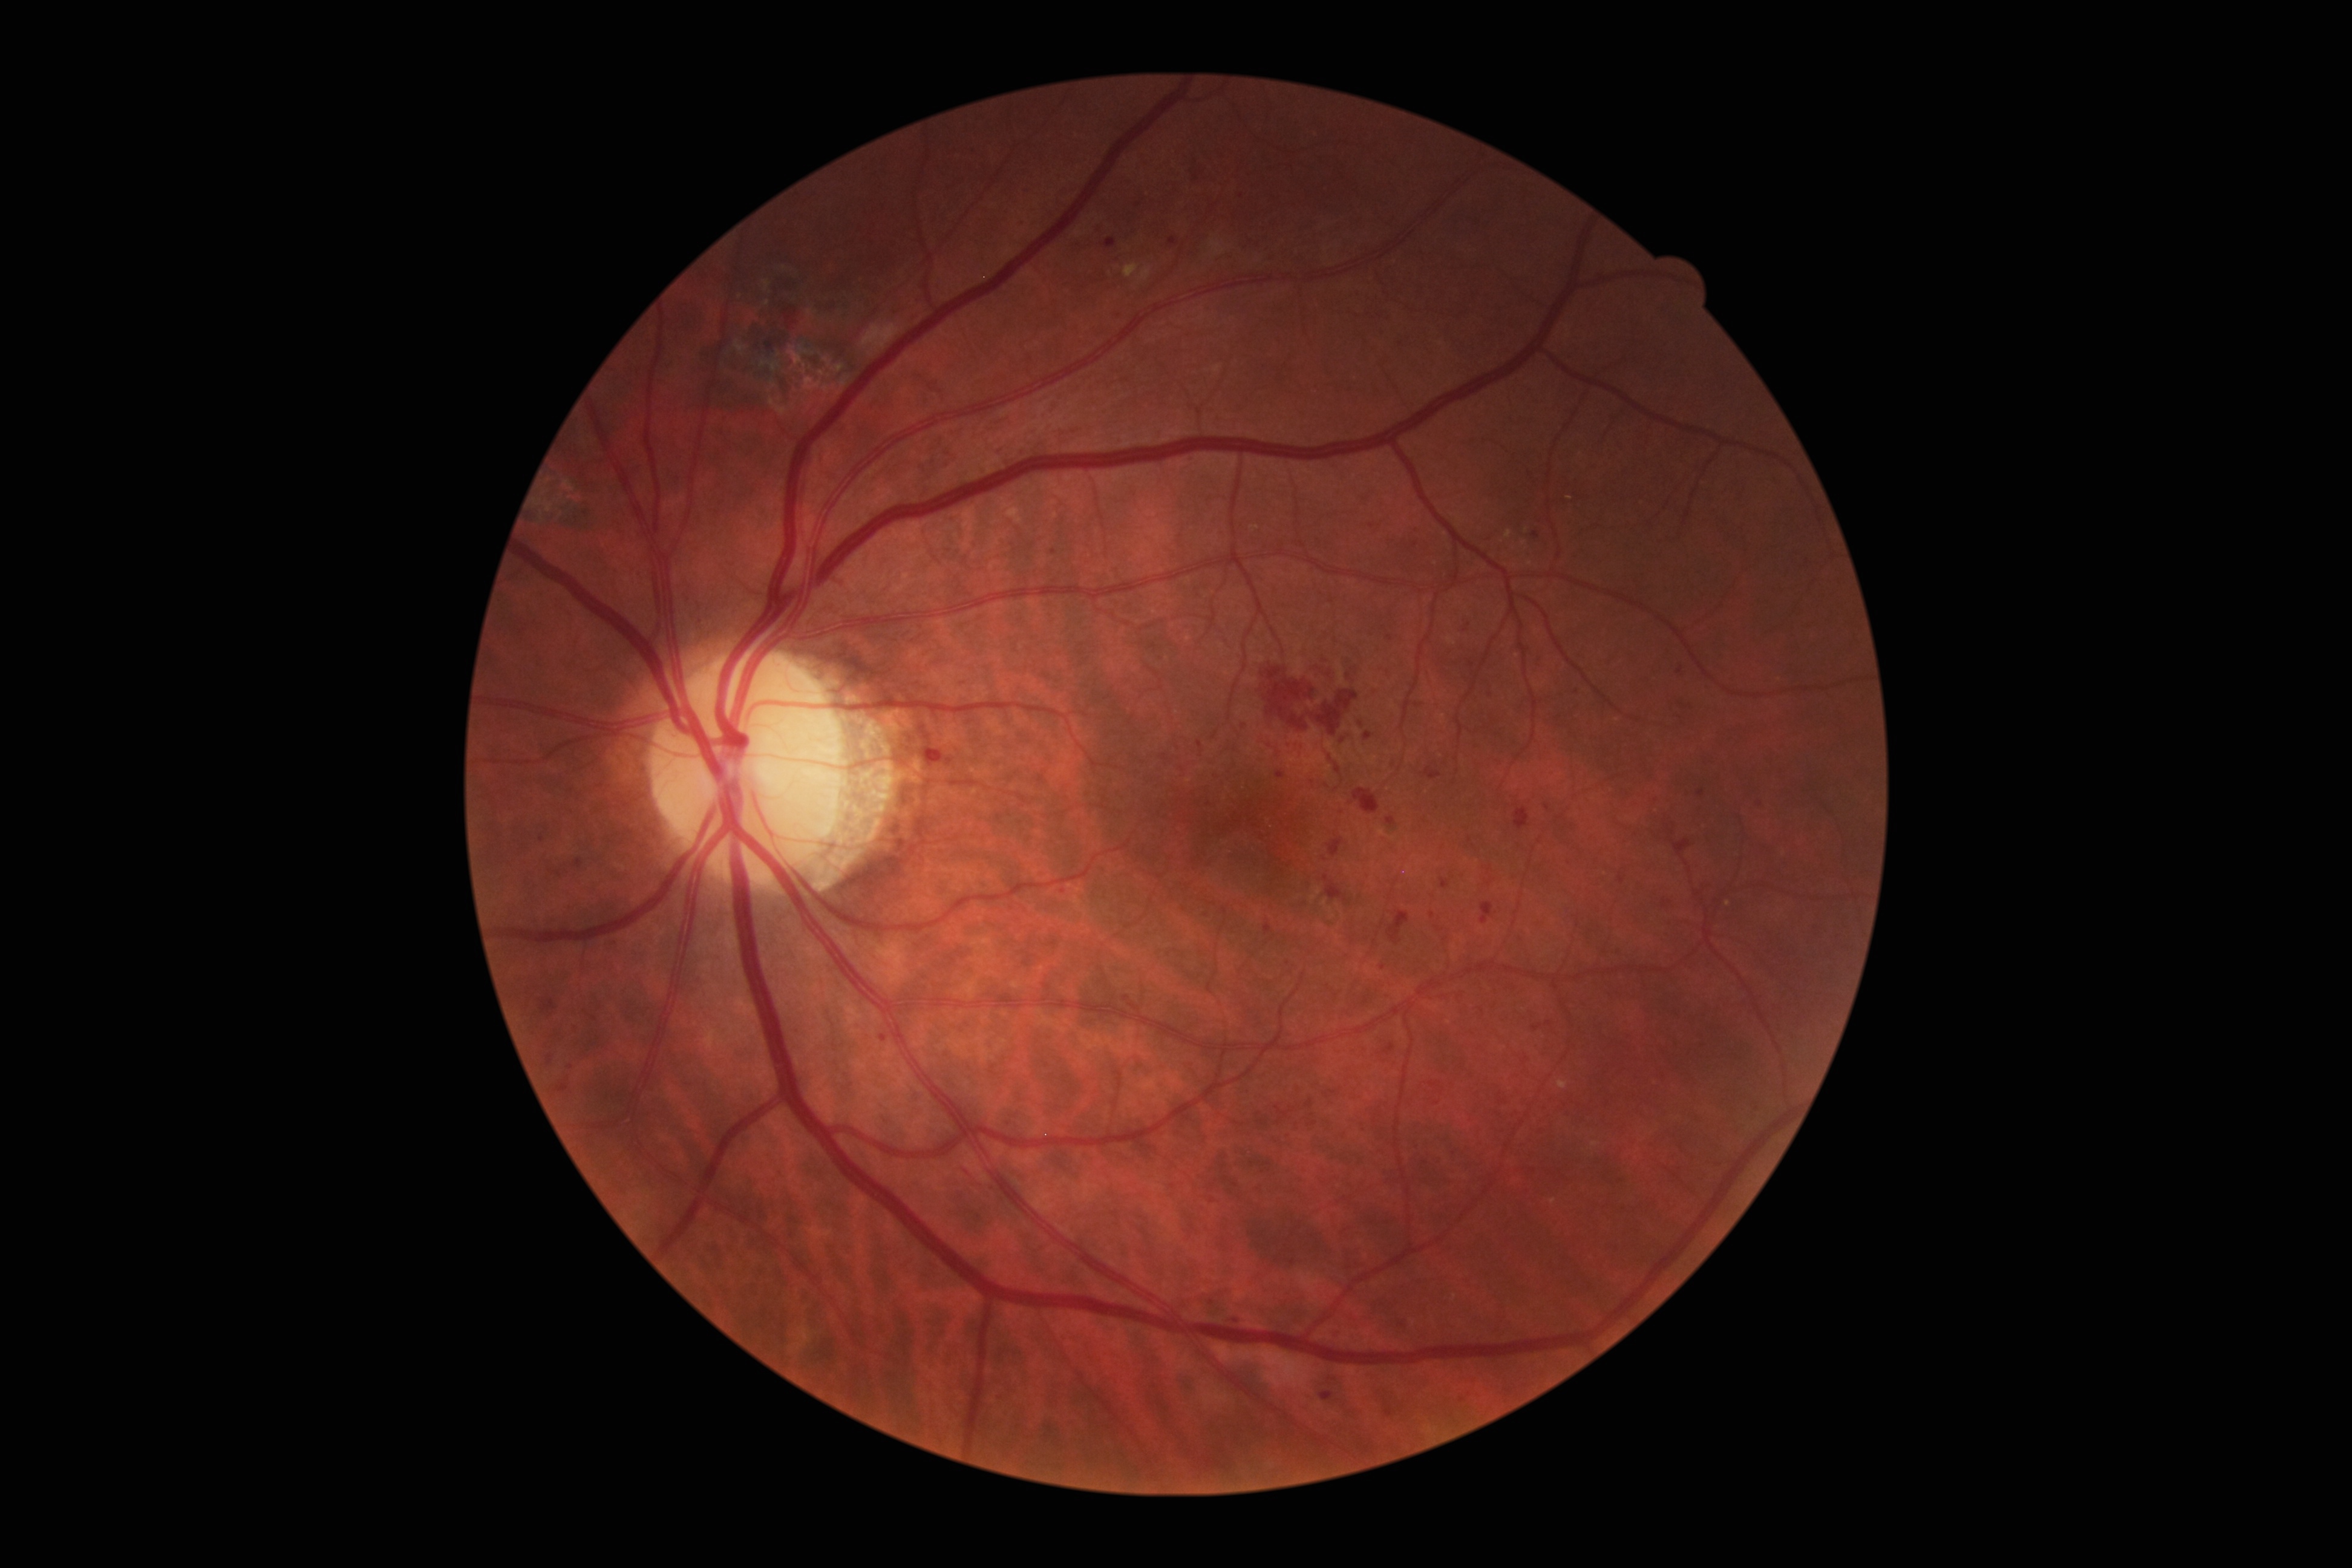 DR grade is moderate non-proliferative diabetic retinopathy (2).